2228x1652px.
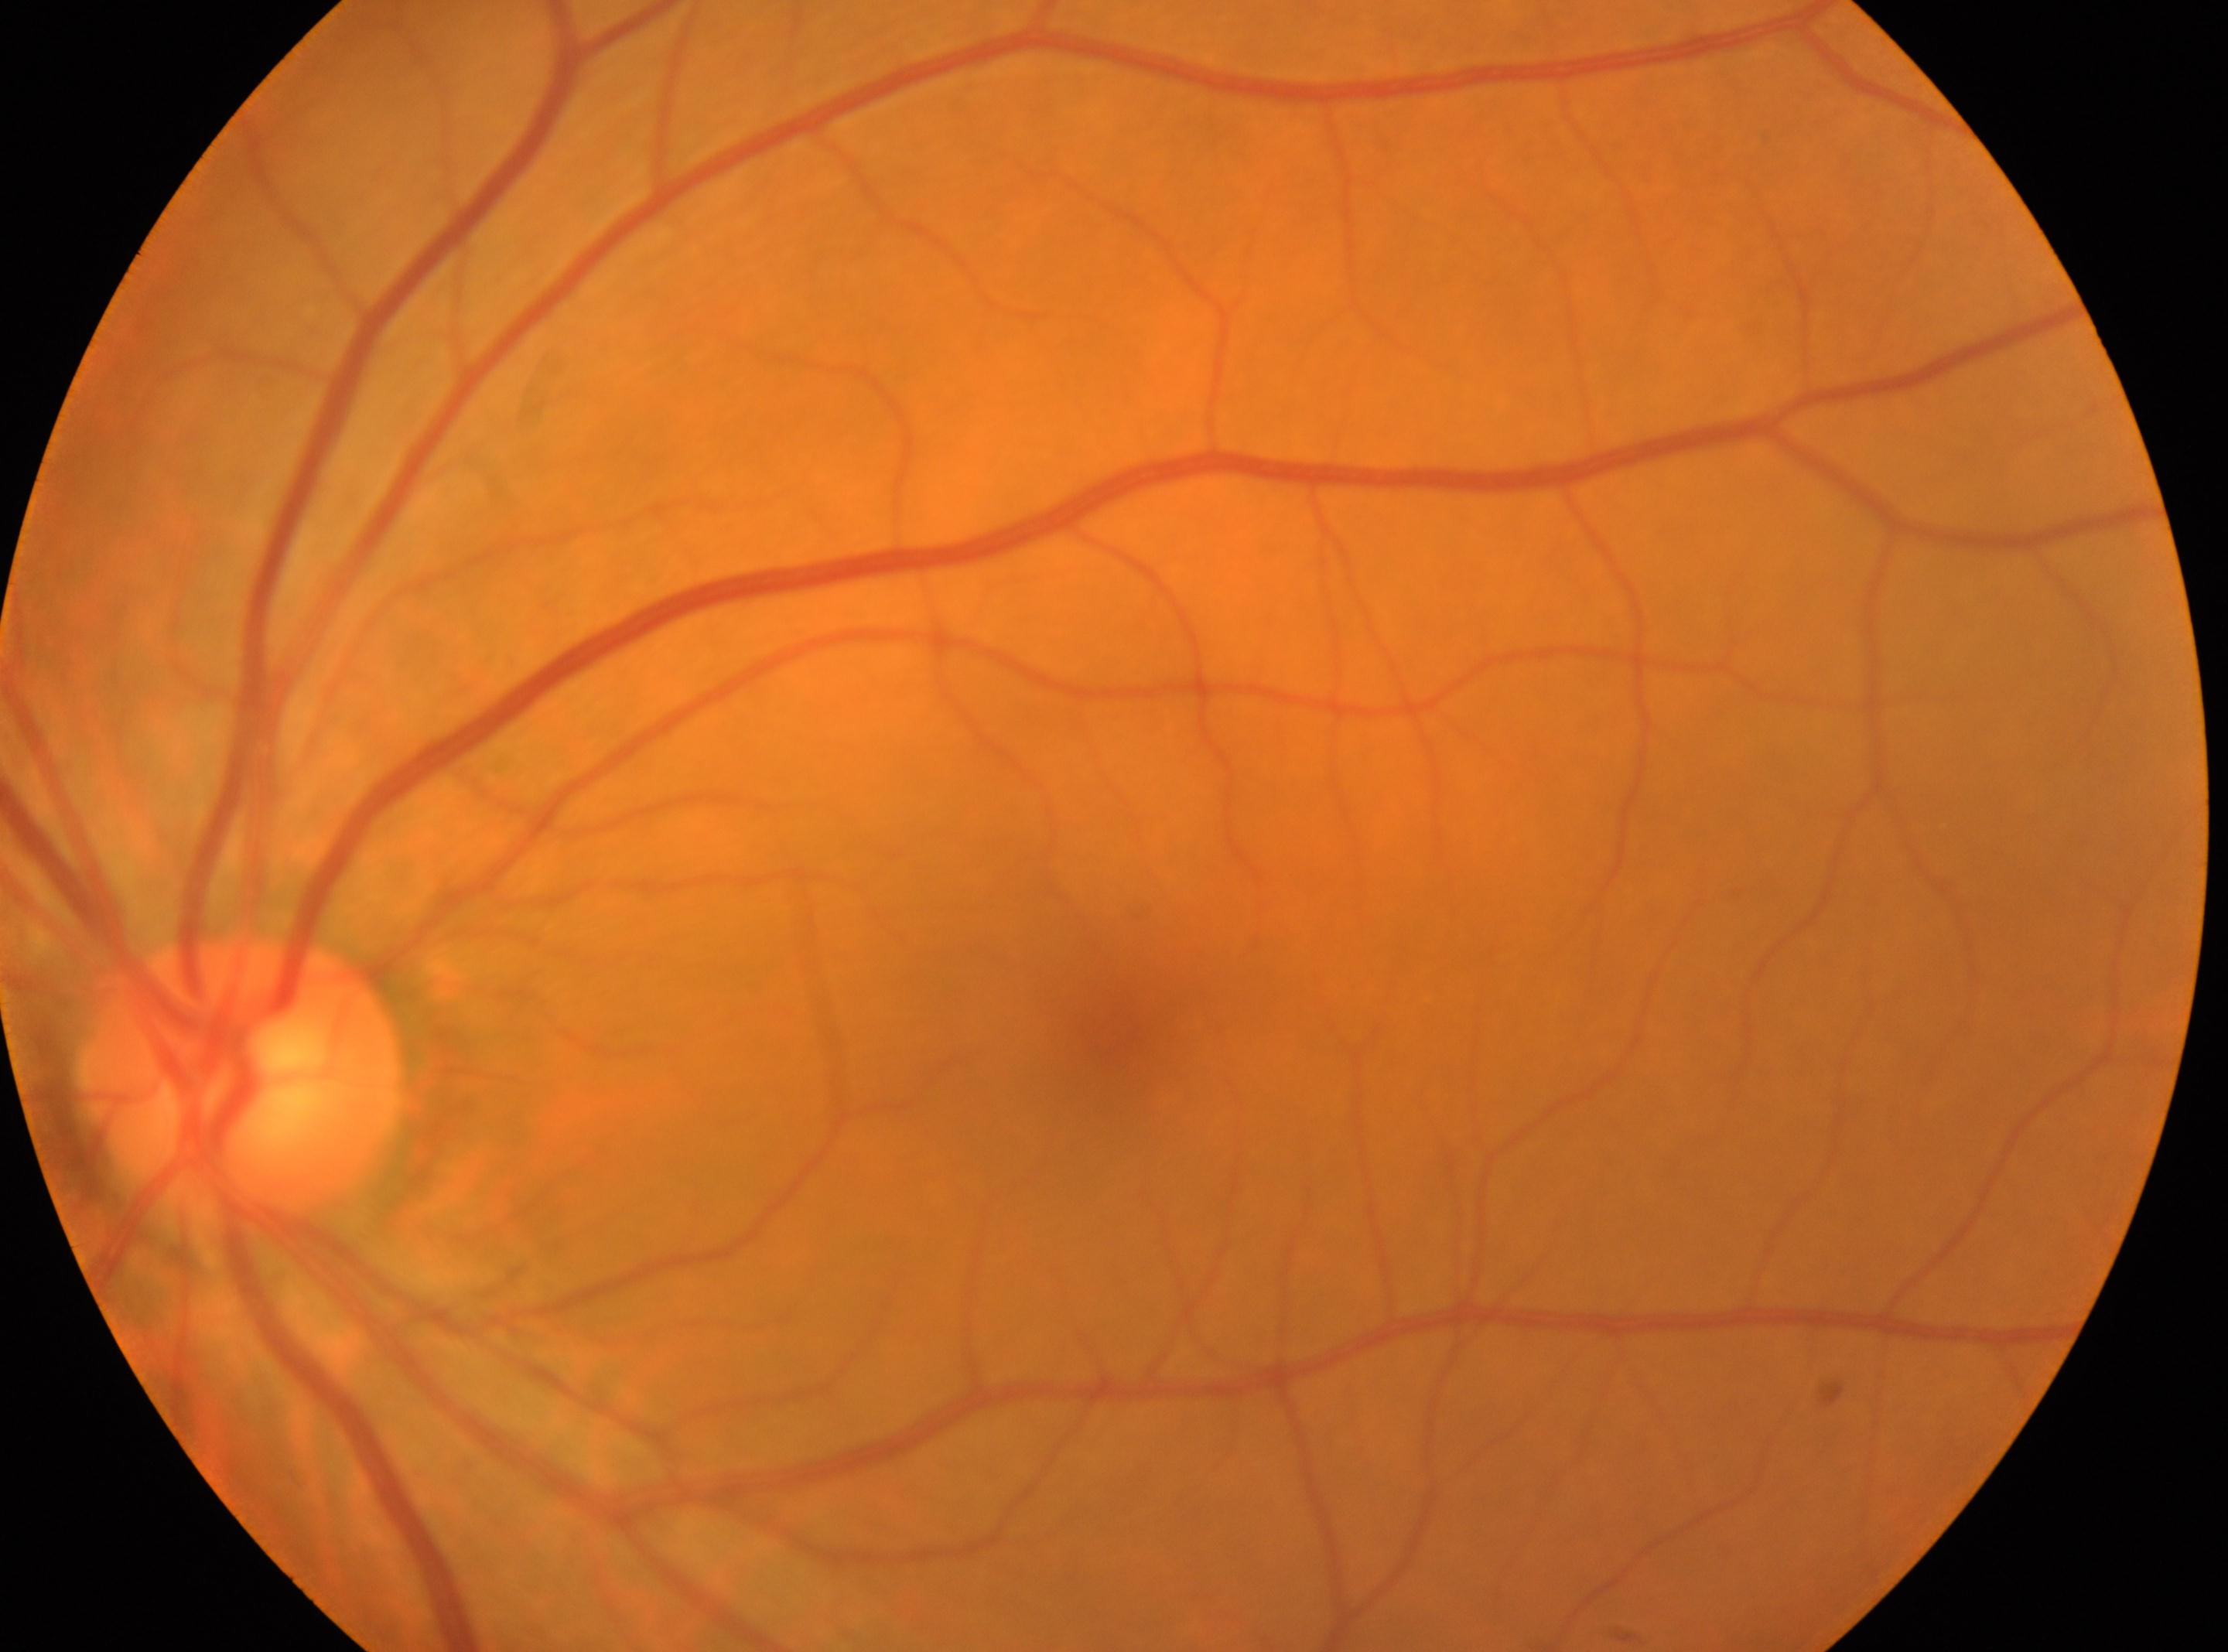
| key | value |
|---|---|
| laterality | left eye |
| diabetic retinopathy | grade 0 |
| fovea | 1102, 1032 |
| ONH | 240, 1080 |
| DR impression | No diabetic retinal disease findings |